FOV: 45 degrees · 2212 x 1659 pixels · color fundus photograph:
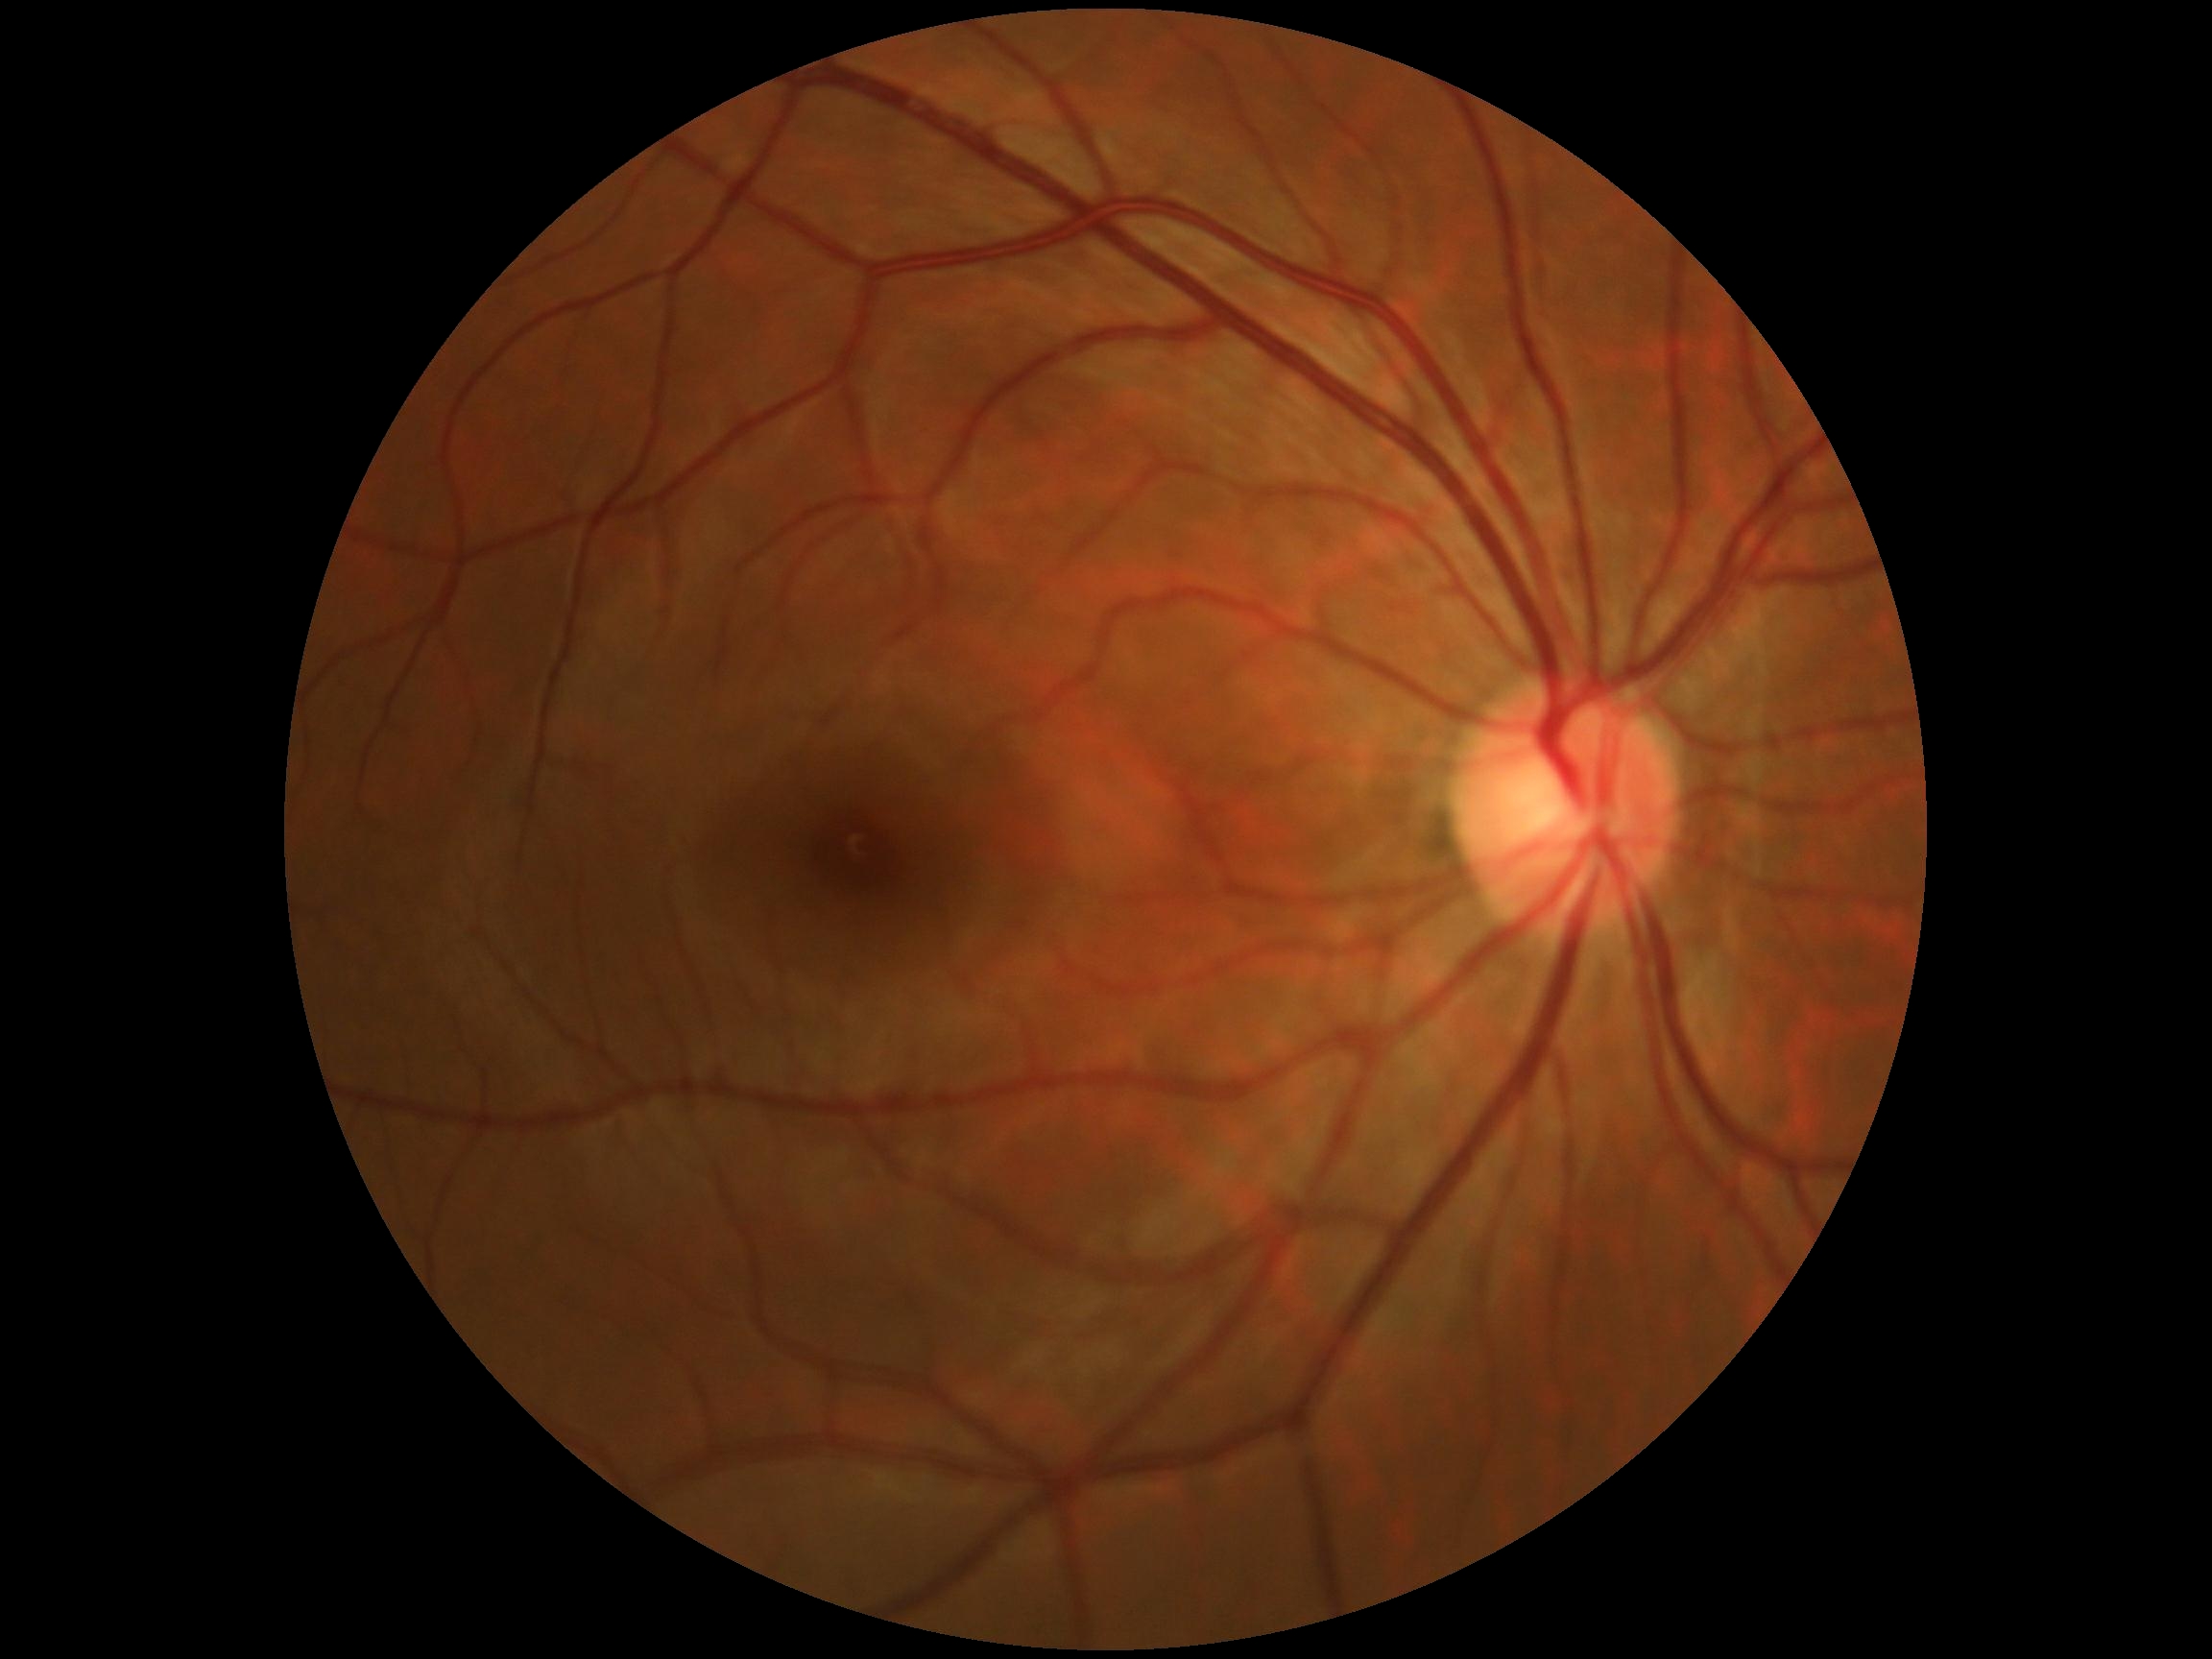 Diabetic retinopathy (DR): 0.